45° FOV · nonmydriatic · 848 x 848 pixels · posterior pole color fundus photograph.
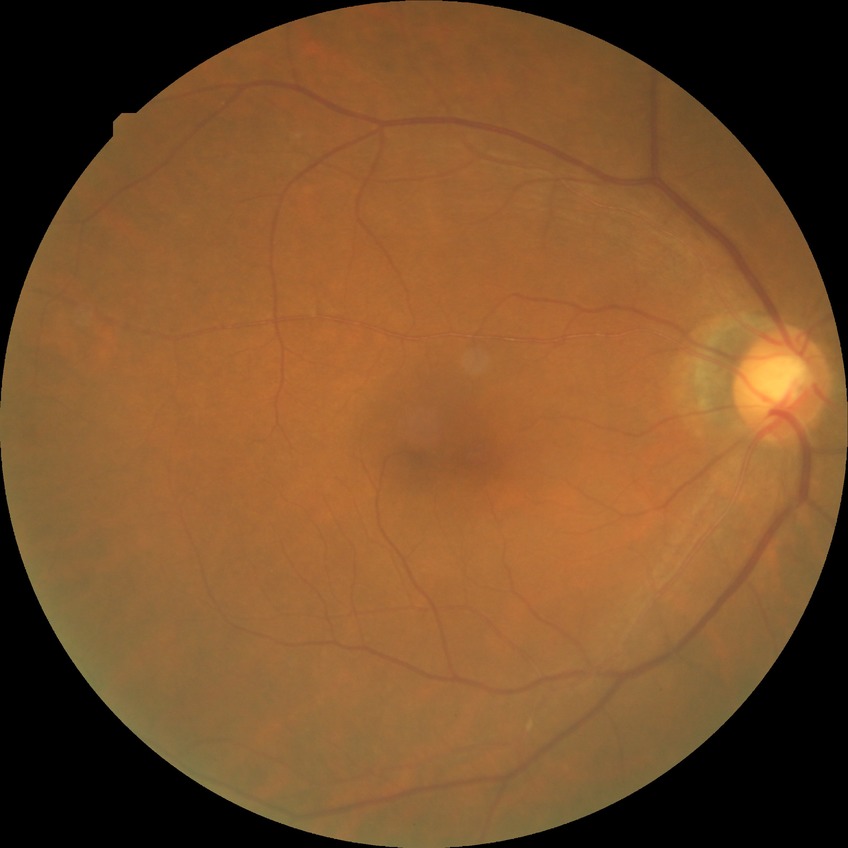 diabetic retinopathy (DR)=NDR (no diabetic retinopathy).